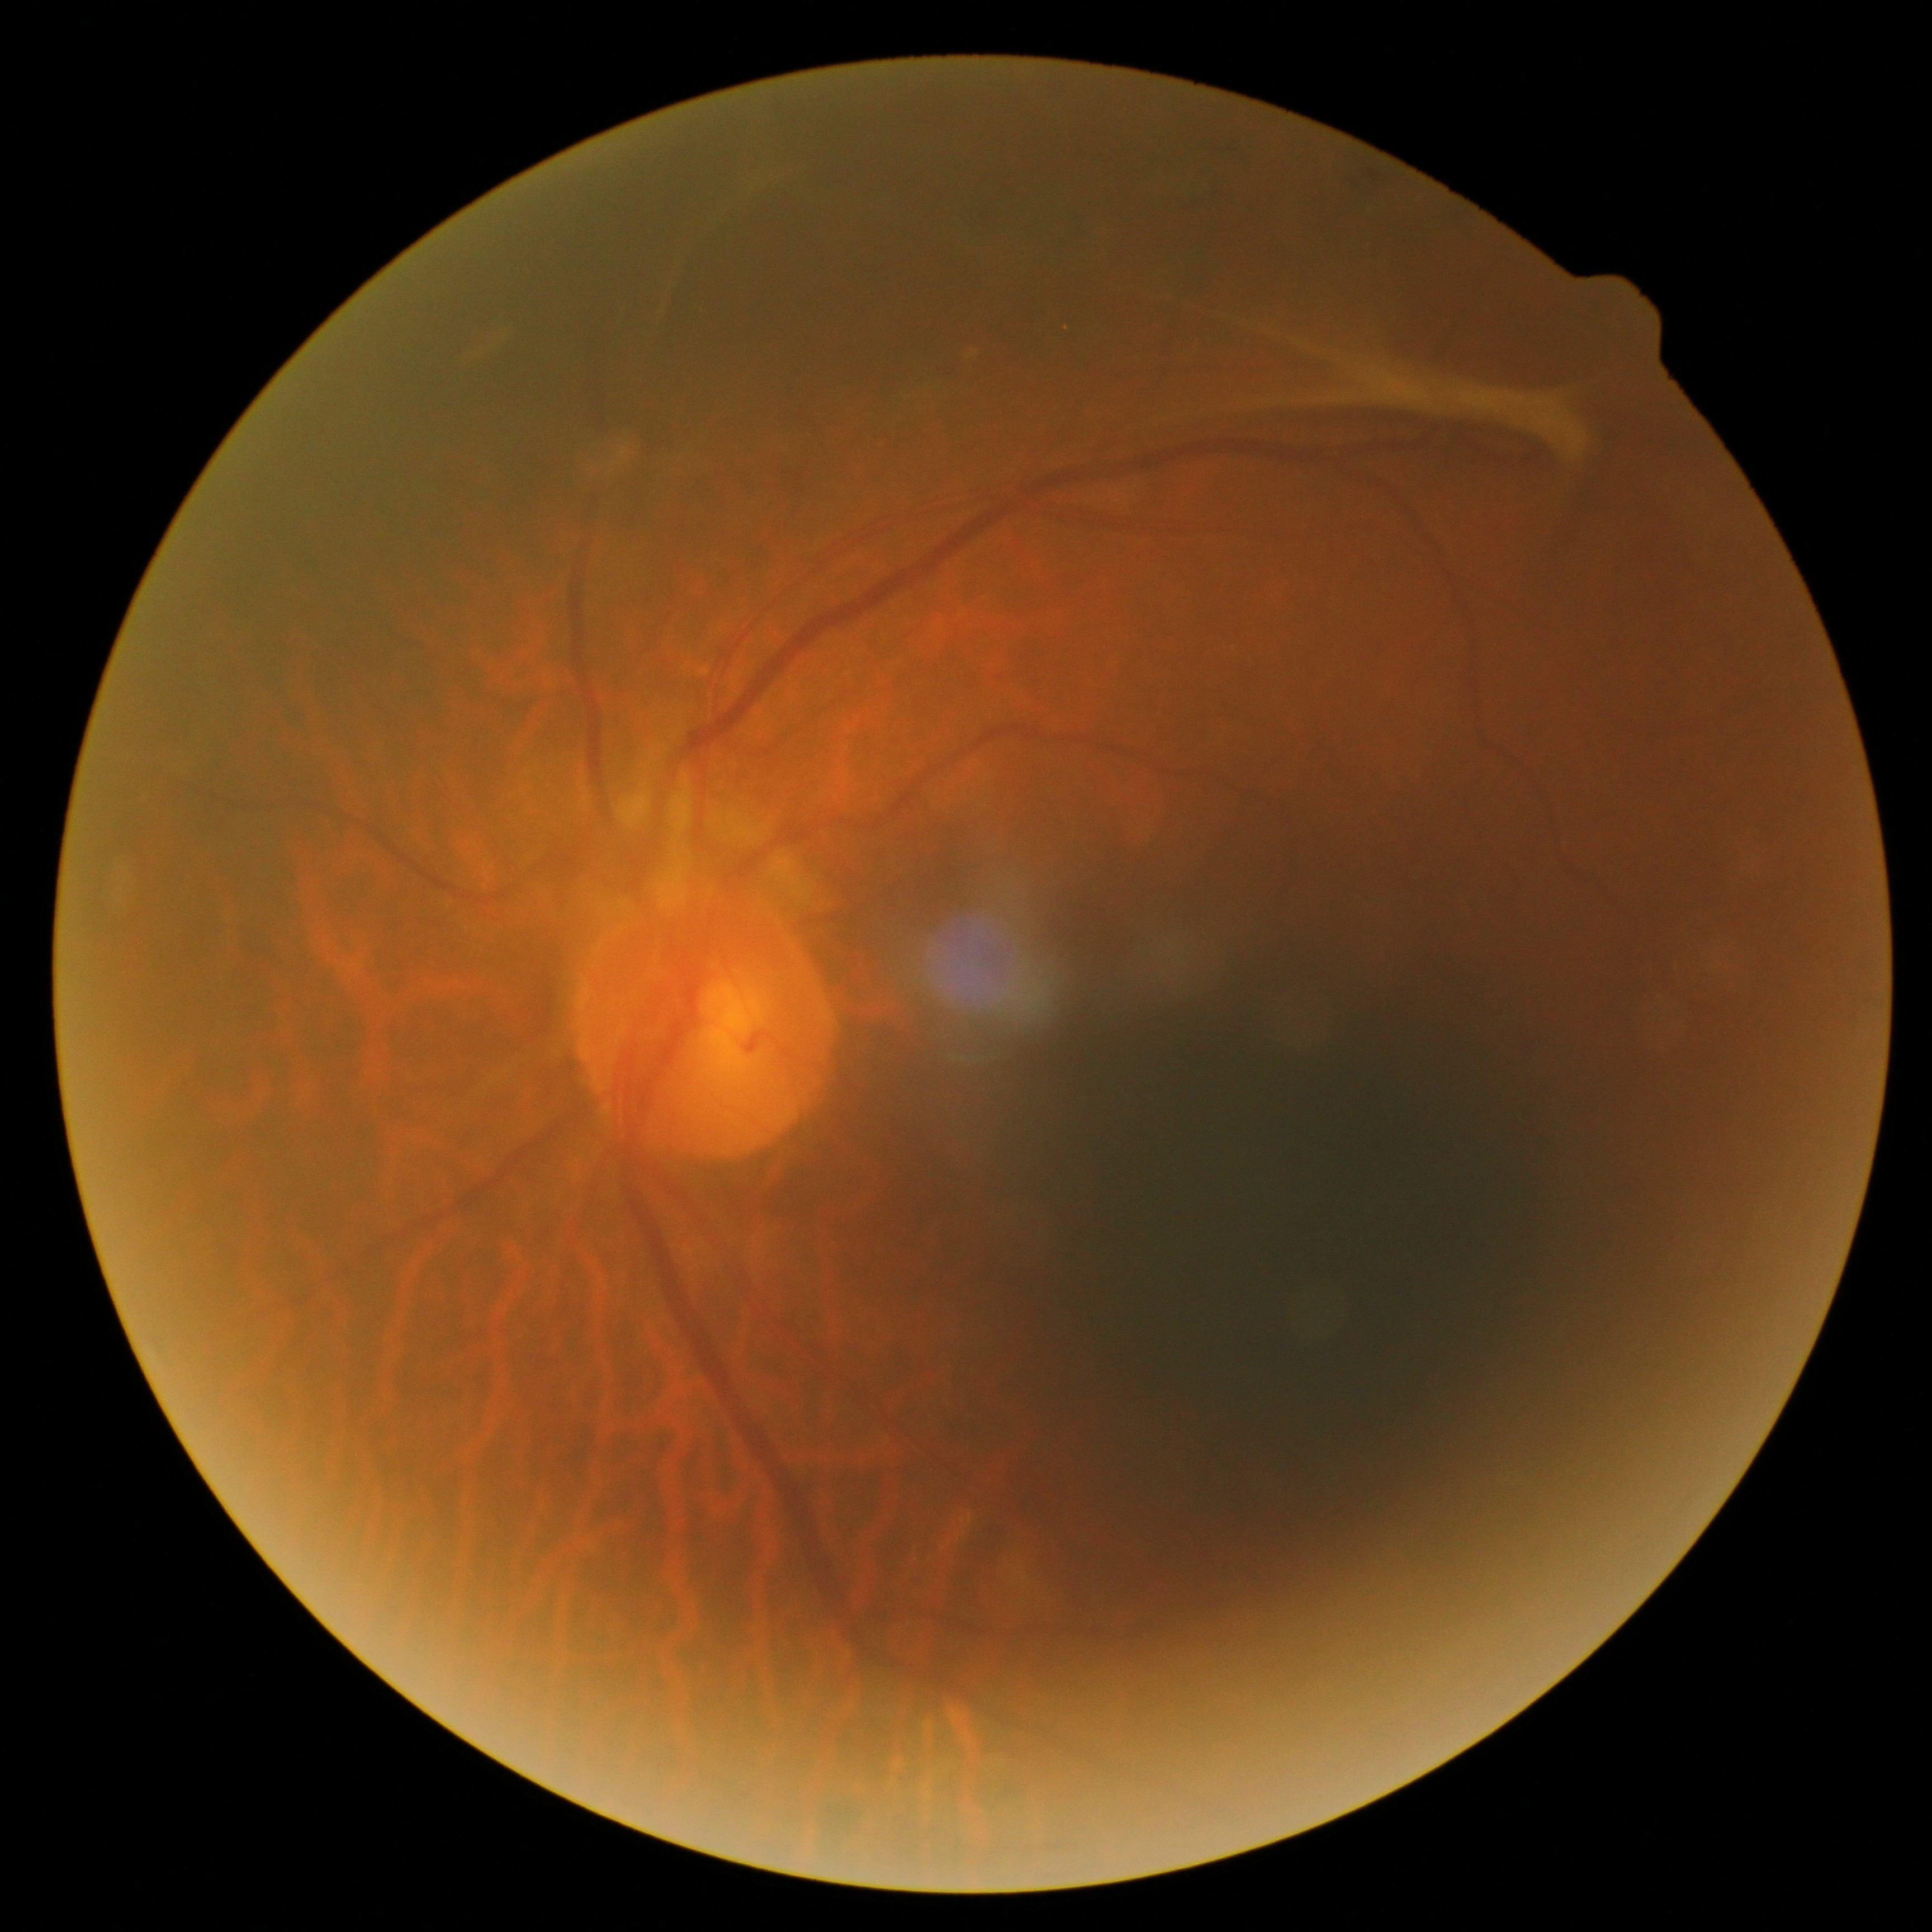 - DR severity: 4/4